Graded on the modified Davis scale · 848 x 848 pixels.
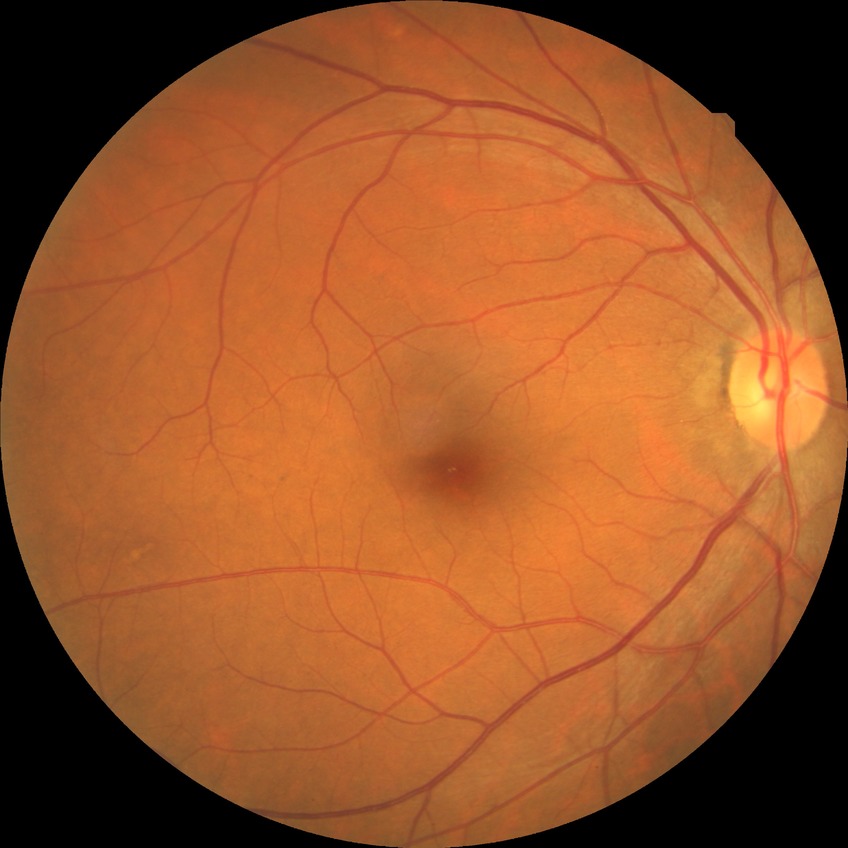
Modified Davis grade is NDR.
No signs of diabetic retinopathy.